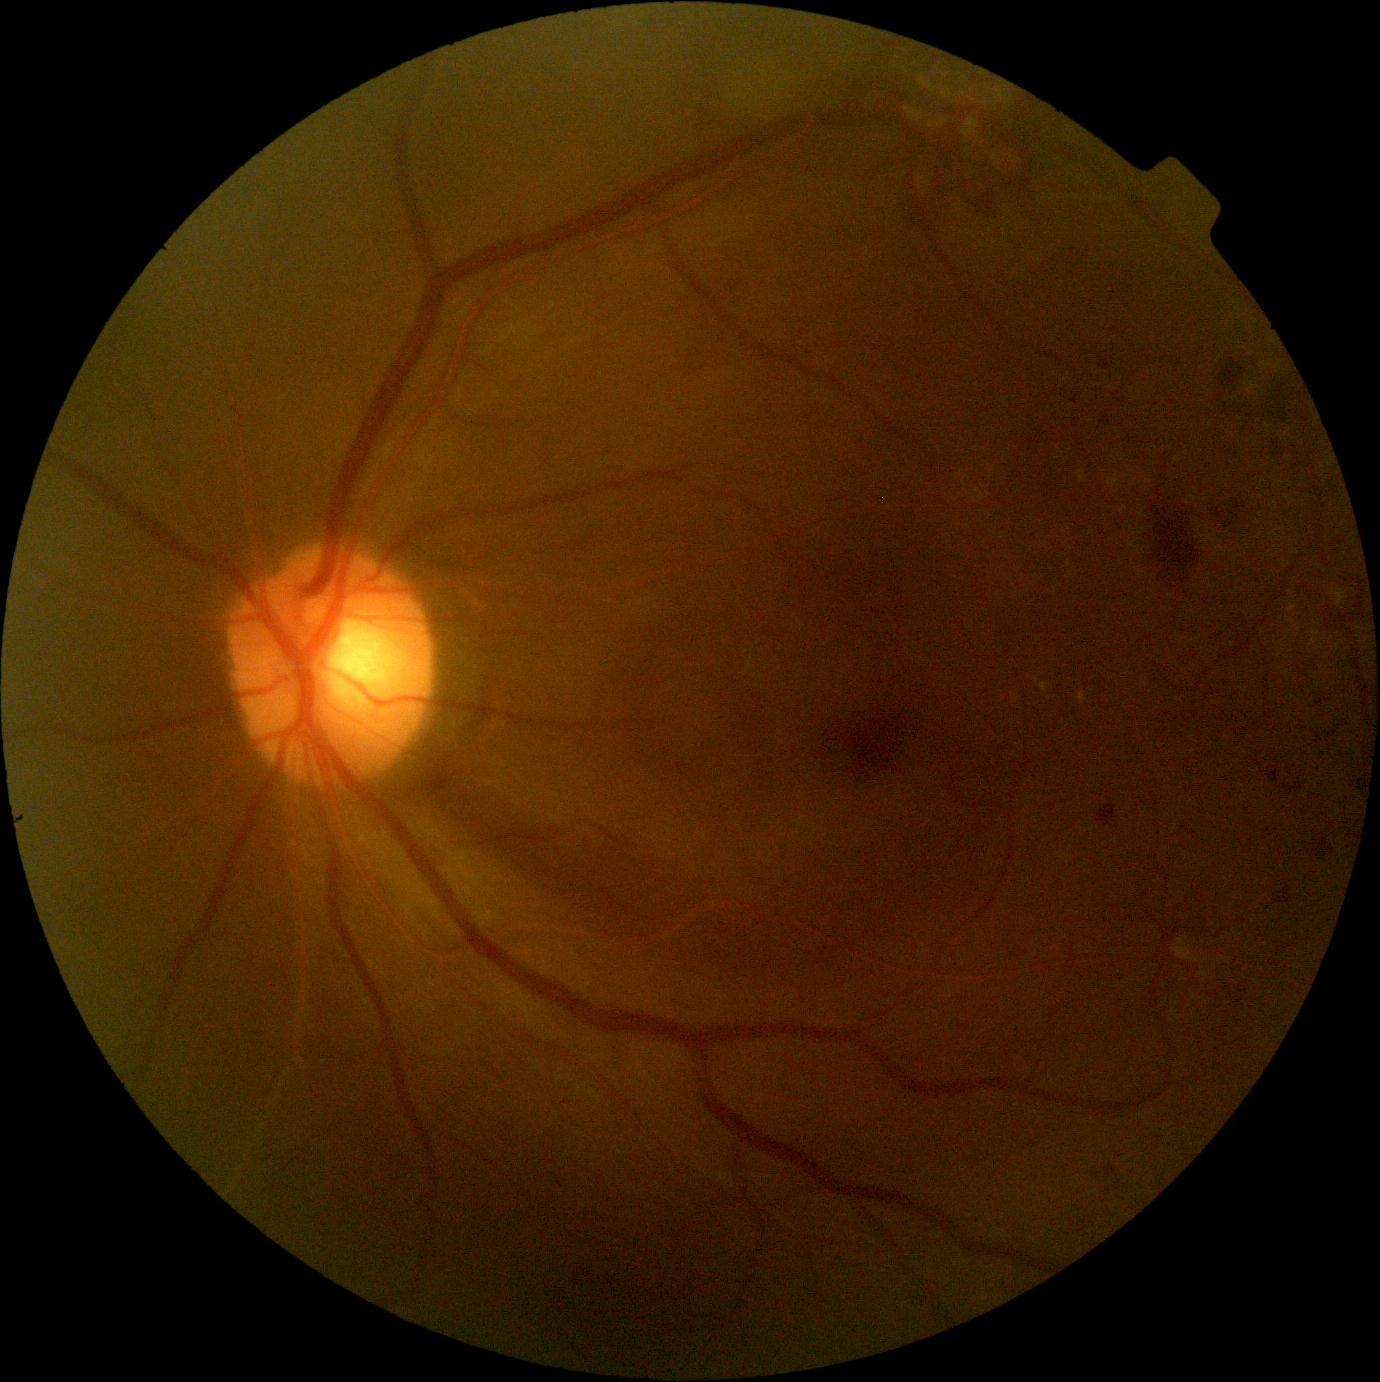

- diabetic retinopathy (DR): grade 2